Color fundus image:
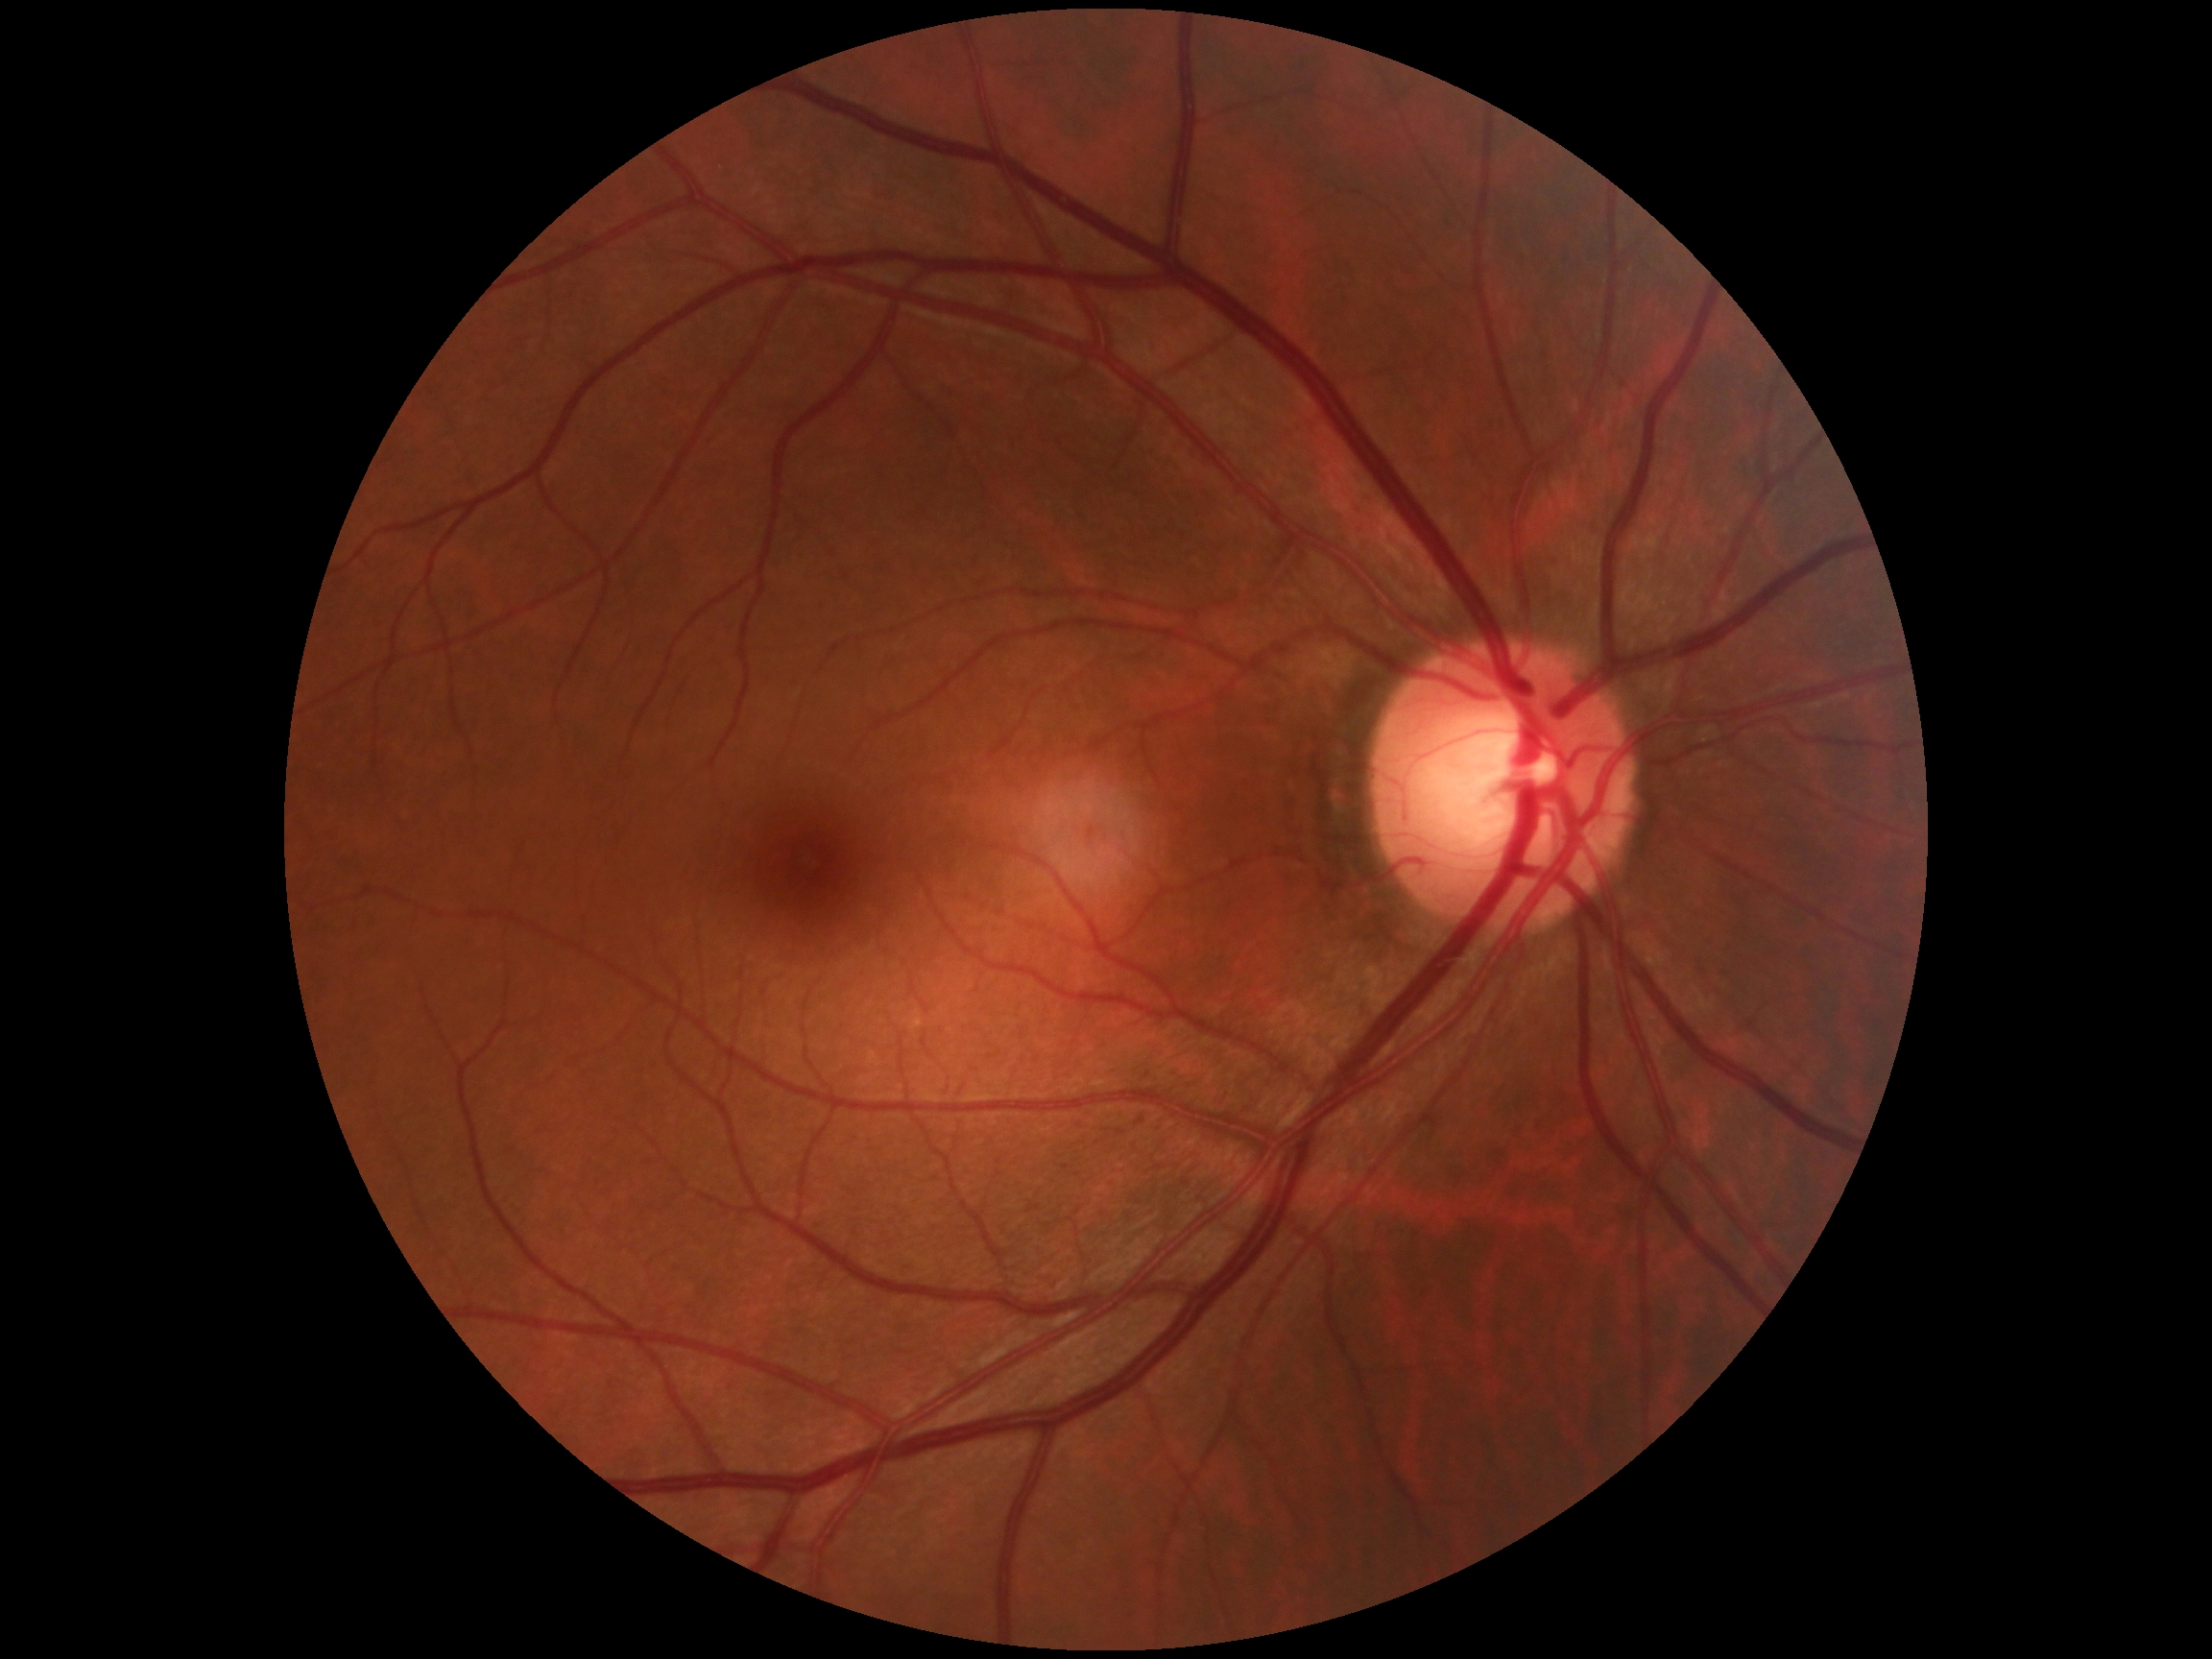

Annotations:
– diabetic retinopathy severity — no apparent diabetic retinopathy (grade 0)
– DR impression — no signs of DR